Image size 2228x1652: 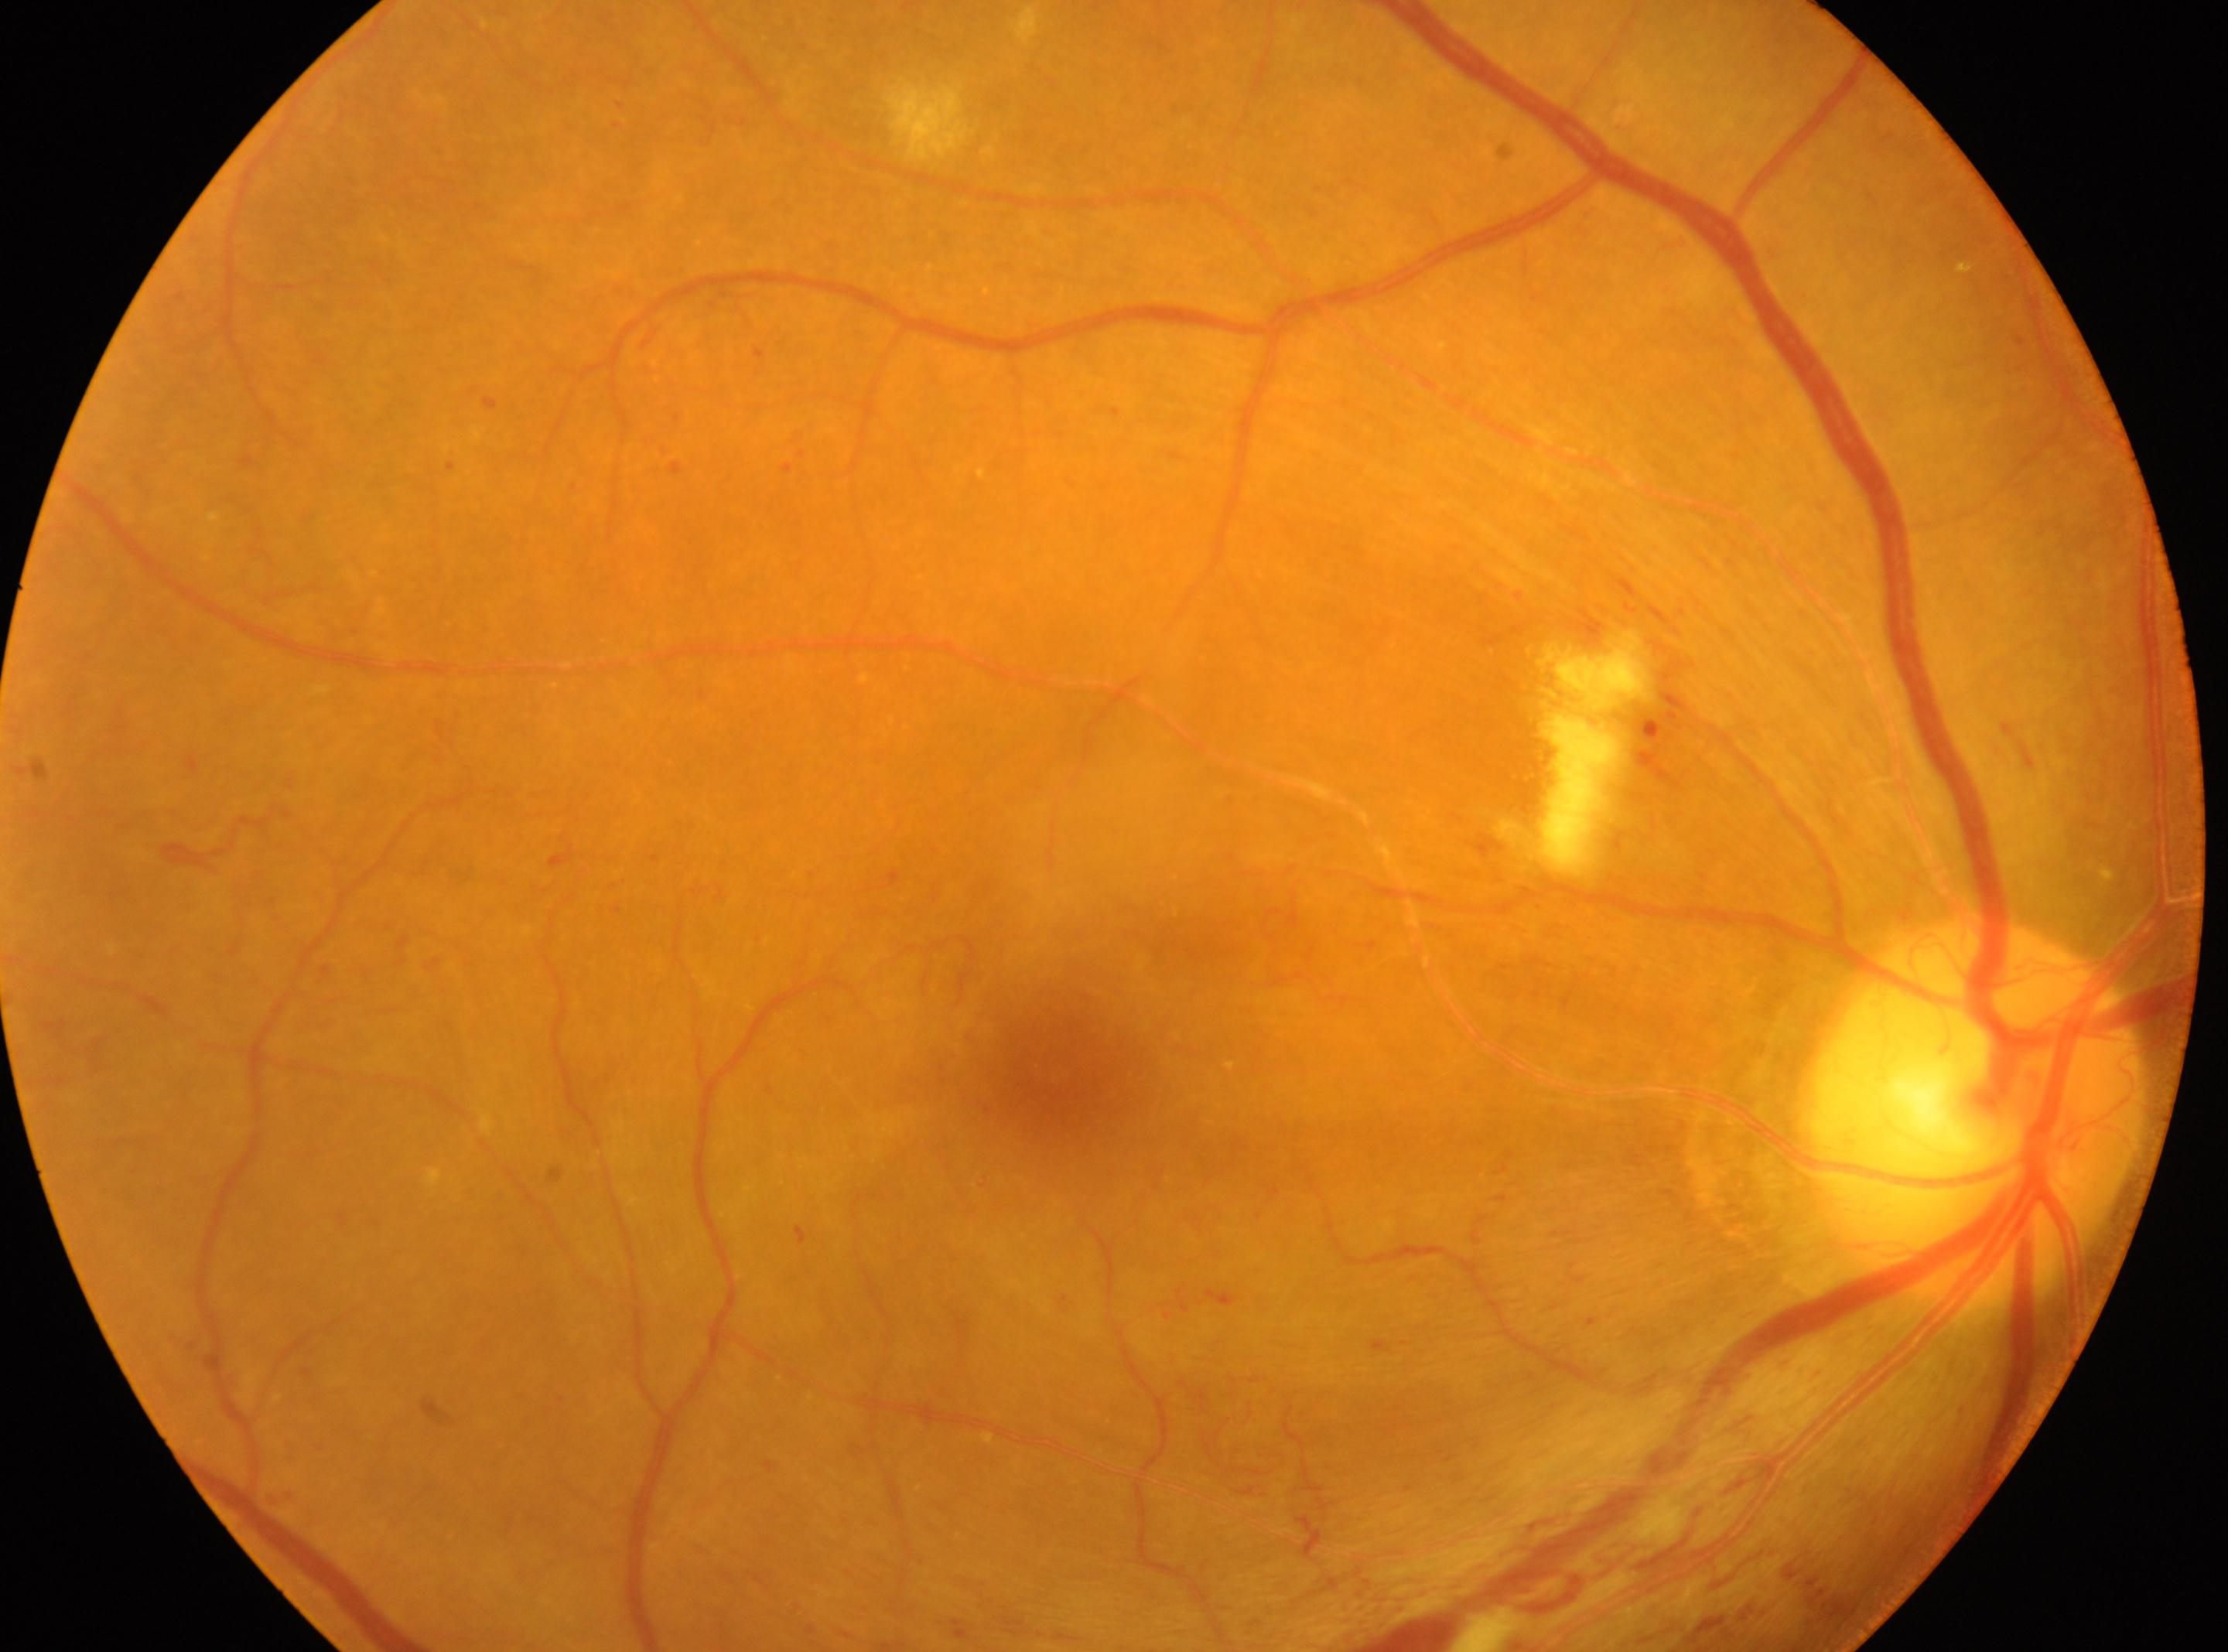 Imaged eye: the right eye.
Foveal center located at (1052,1072).
The optic disc is at (1973,1111).
DR stage: grade 4.